Diabetic retinopathy graded by the modified Davis classification; nonmydriatic fundus photograph
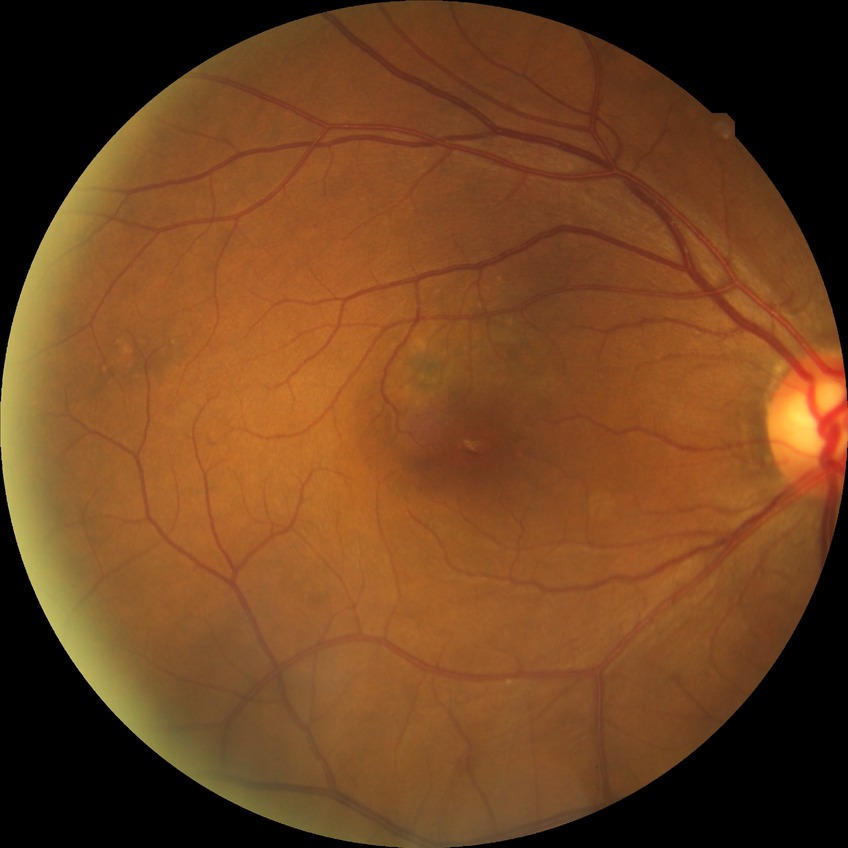

Diabetic retinopathy (DR) is no diabetic retinopathy (NDR).